1240x1240px; 100° field of view (Phoenix ICON); wide-field fundus image from infant ROP screening
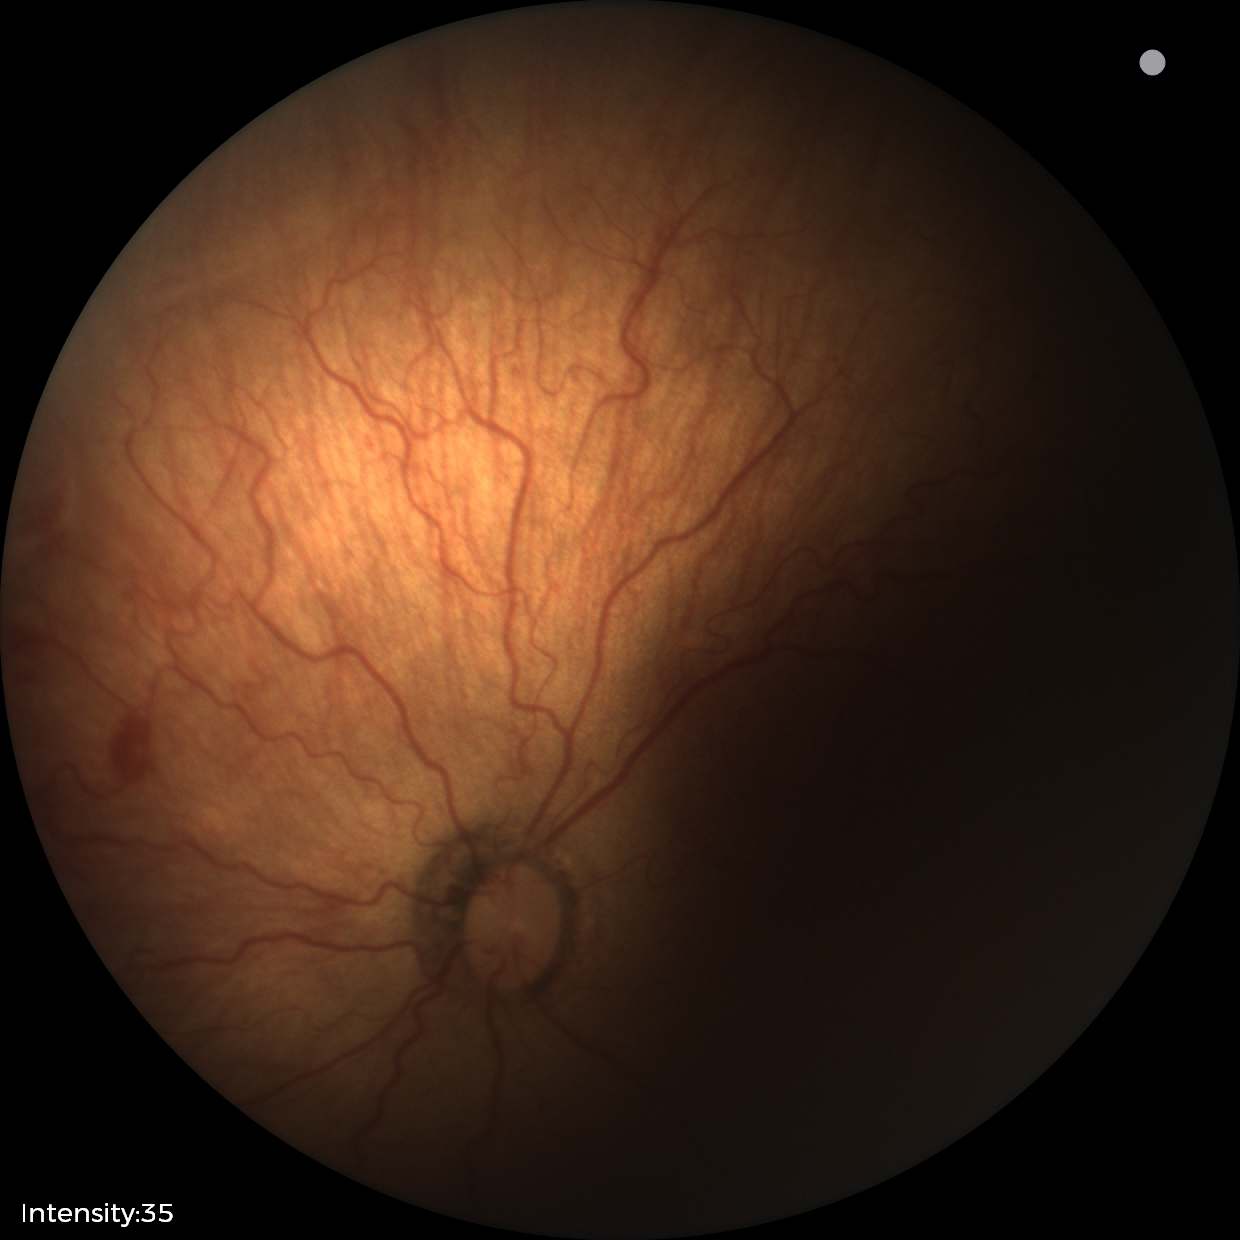
With plus disease. Series diagnosed as retinopathy of prematurity (ROP) stage 2 — ridge with height and width at the demarcation line.